2352 by 1568 pixels; 45-degree field of view.
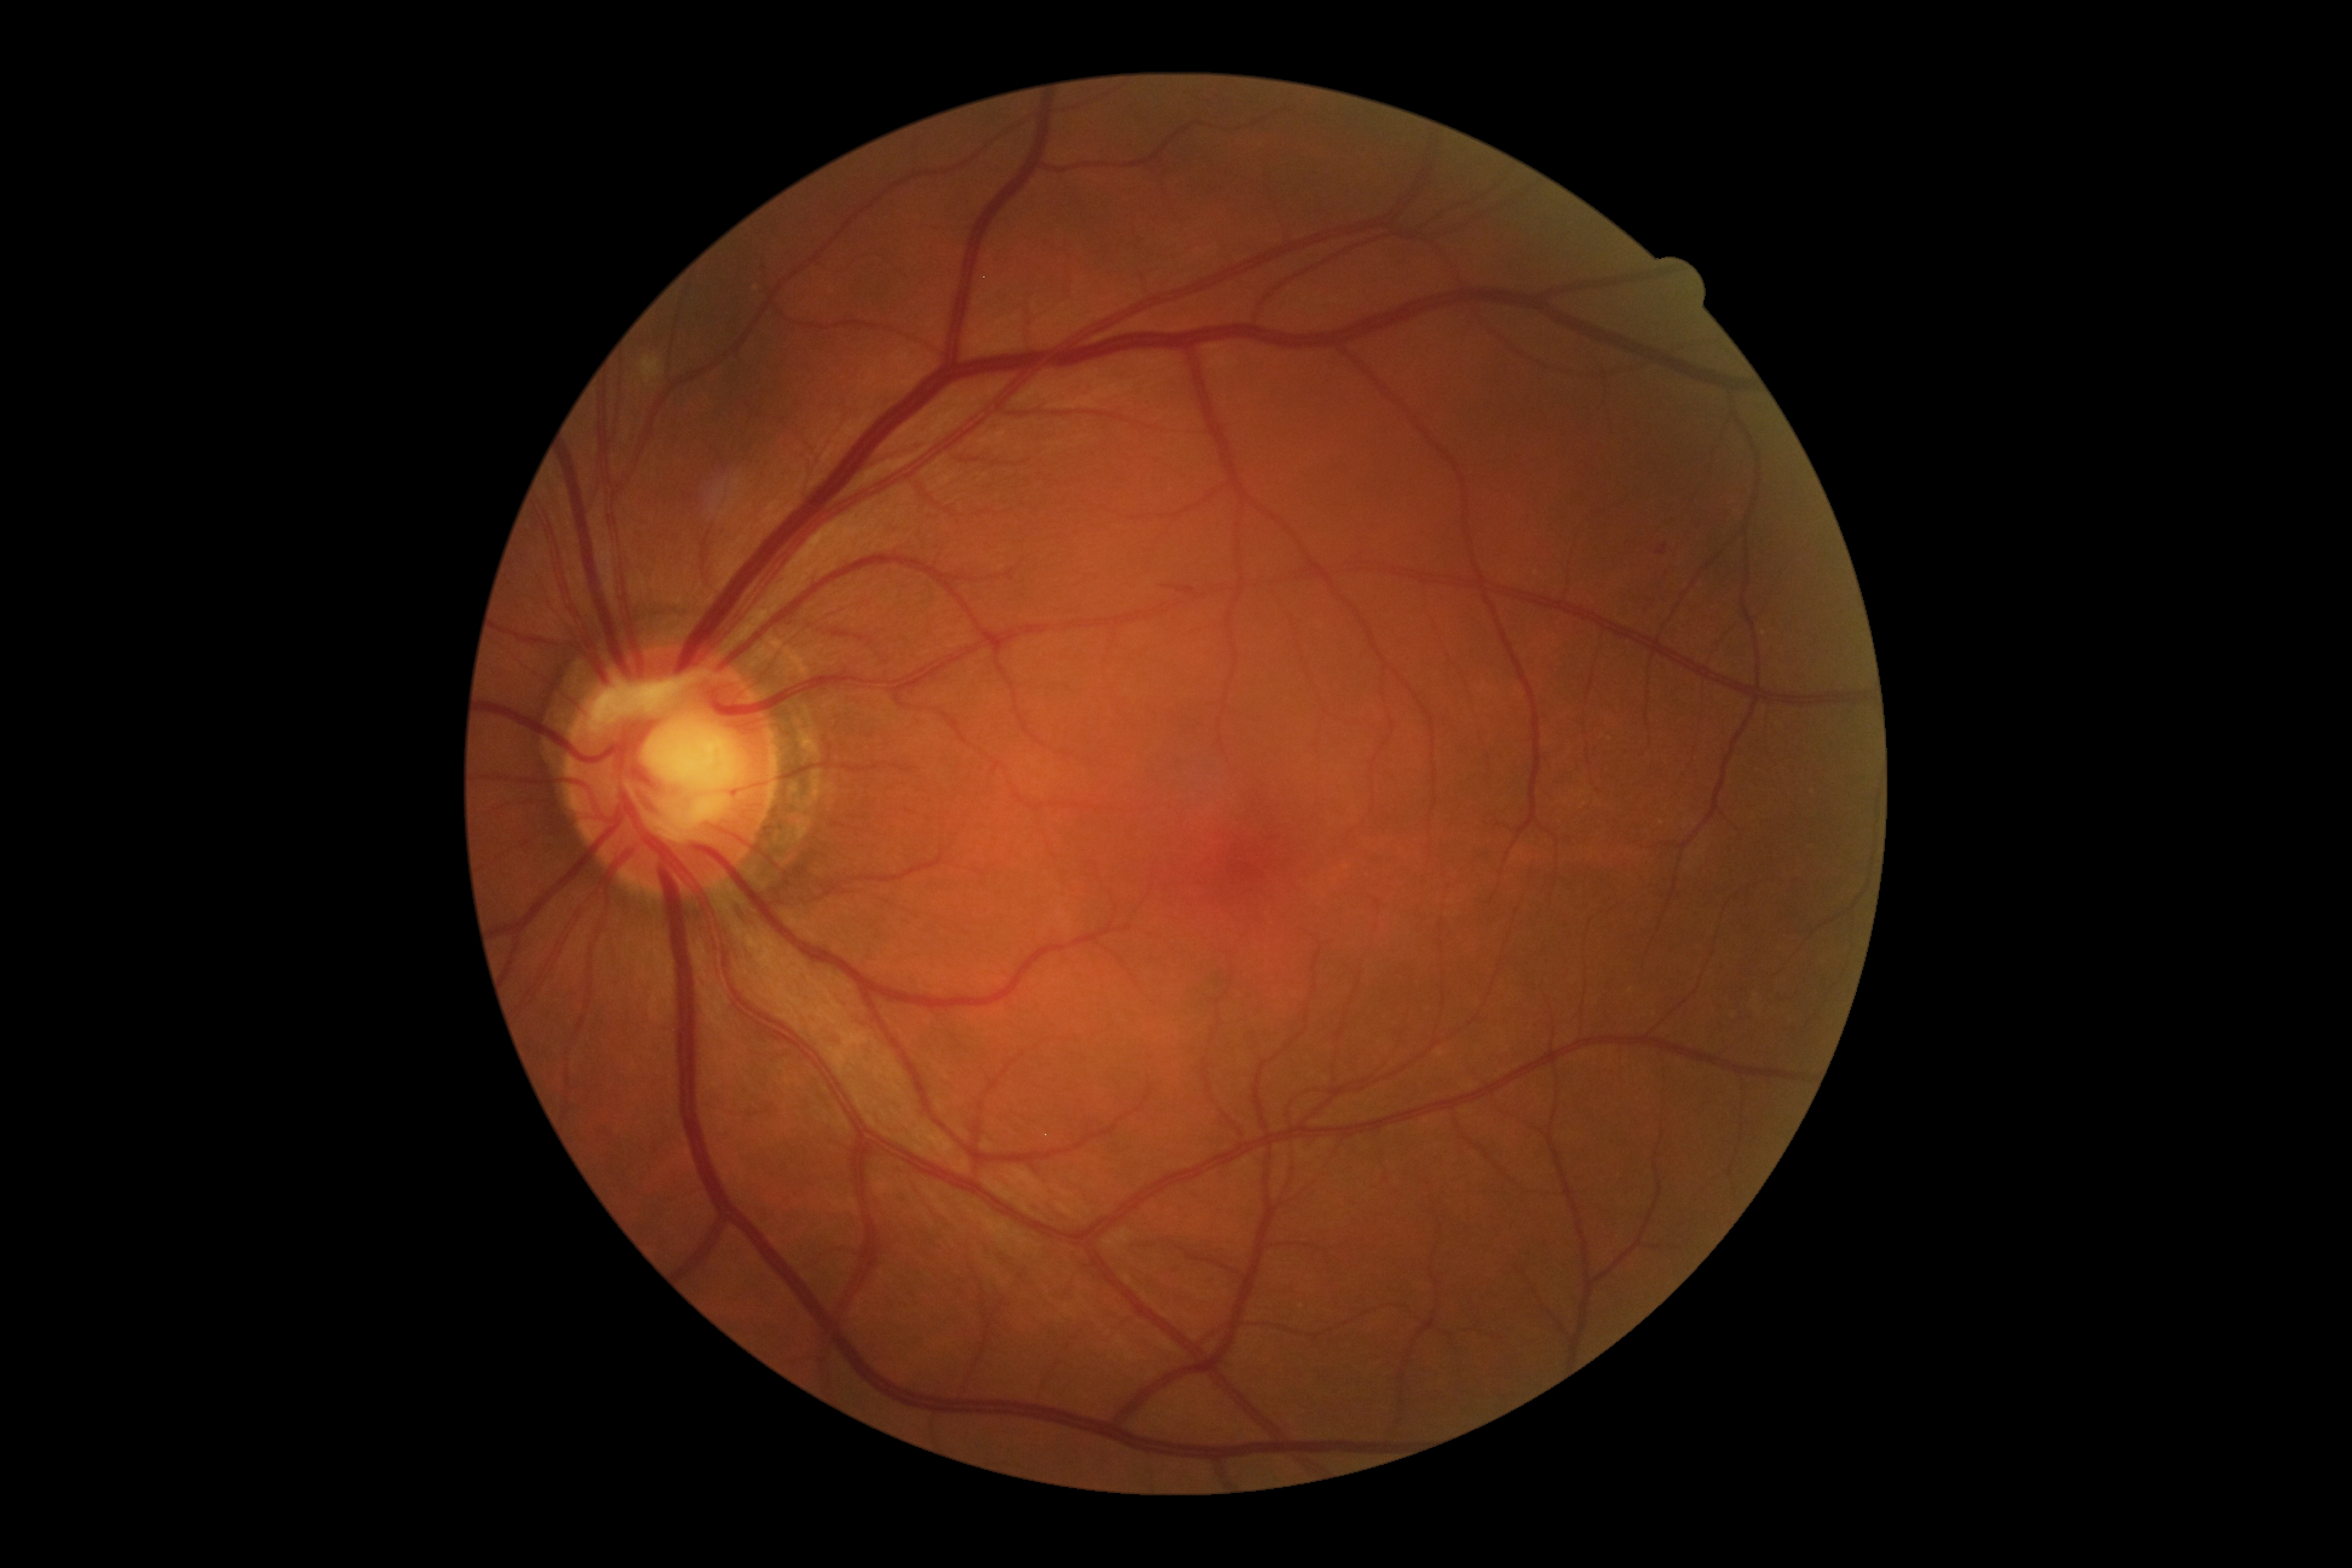

retinopathy: moderate non-proliferative diabetic retinopathy (grade 2); DR class: non-proliferative diabetic retinopathy.